Portable fundus photograph
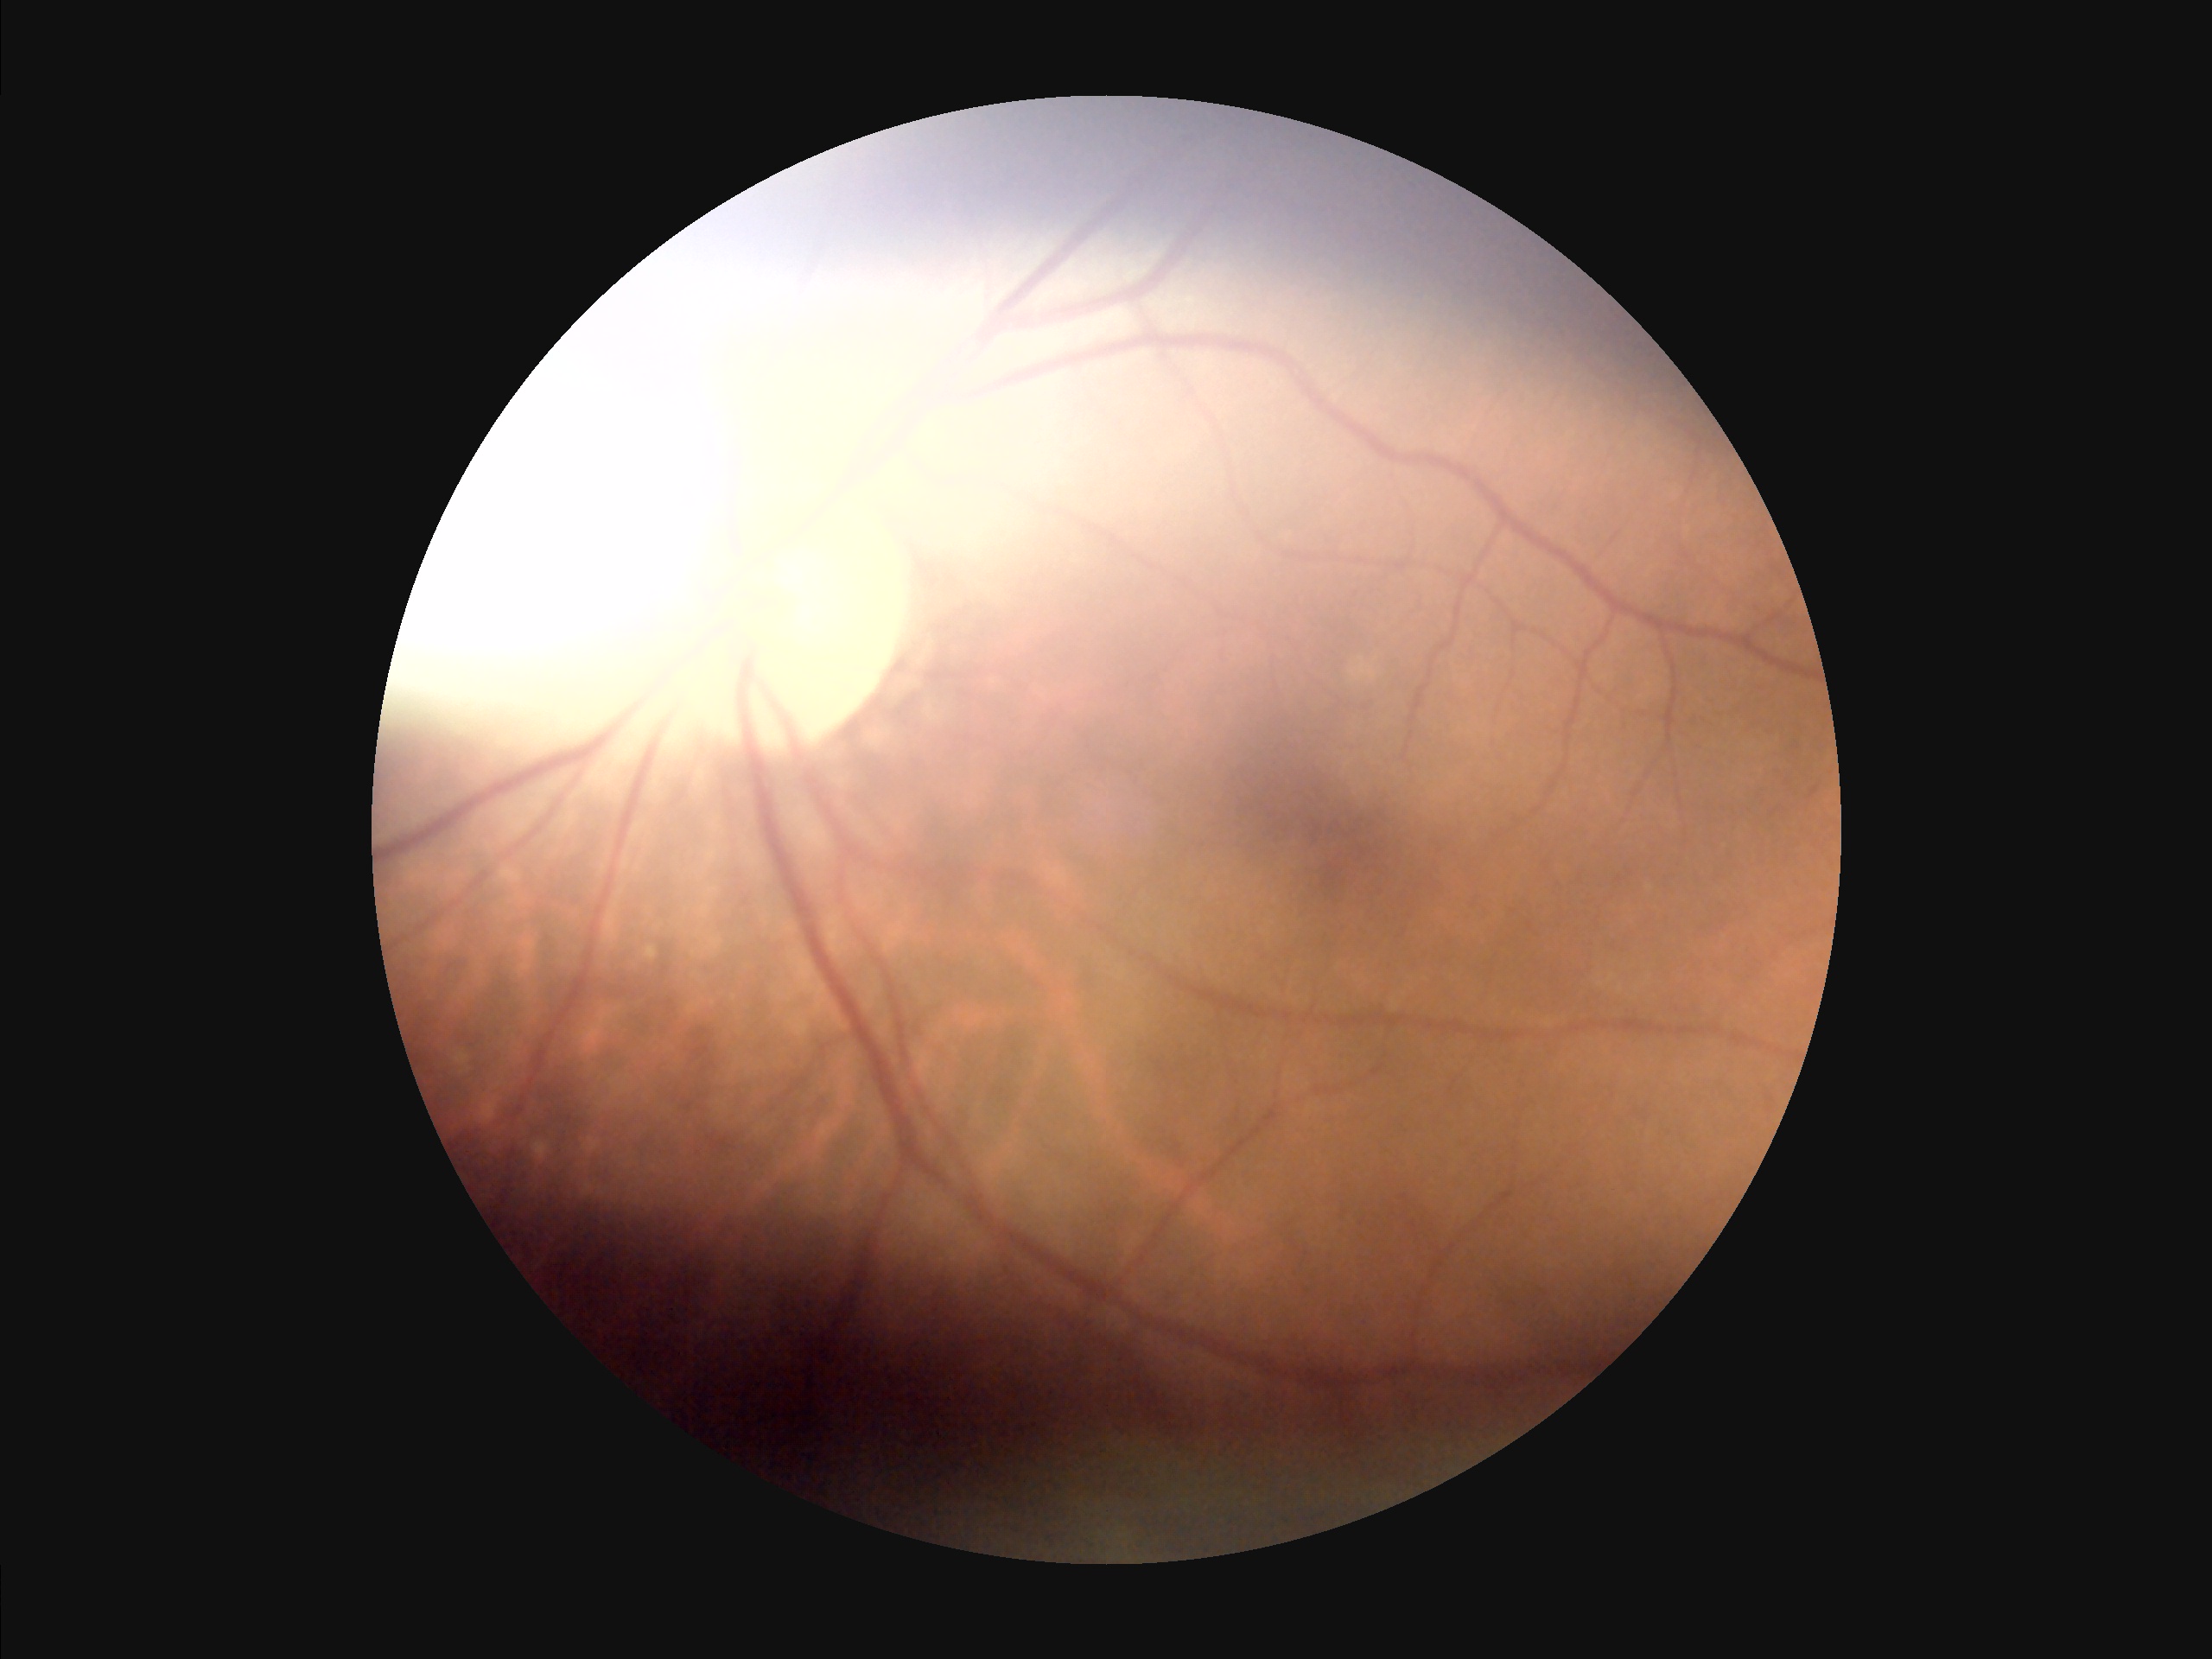

illumination: uneven
contrast: good
overall_quality: suboptimal
clarity: in focus